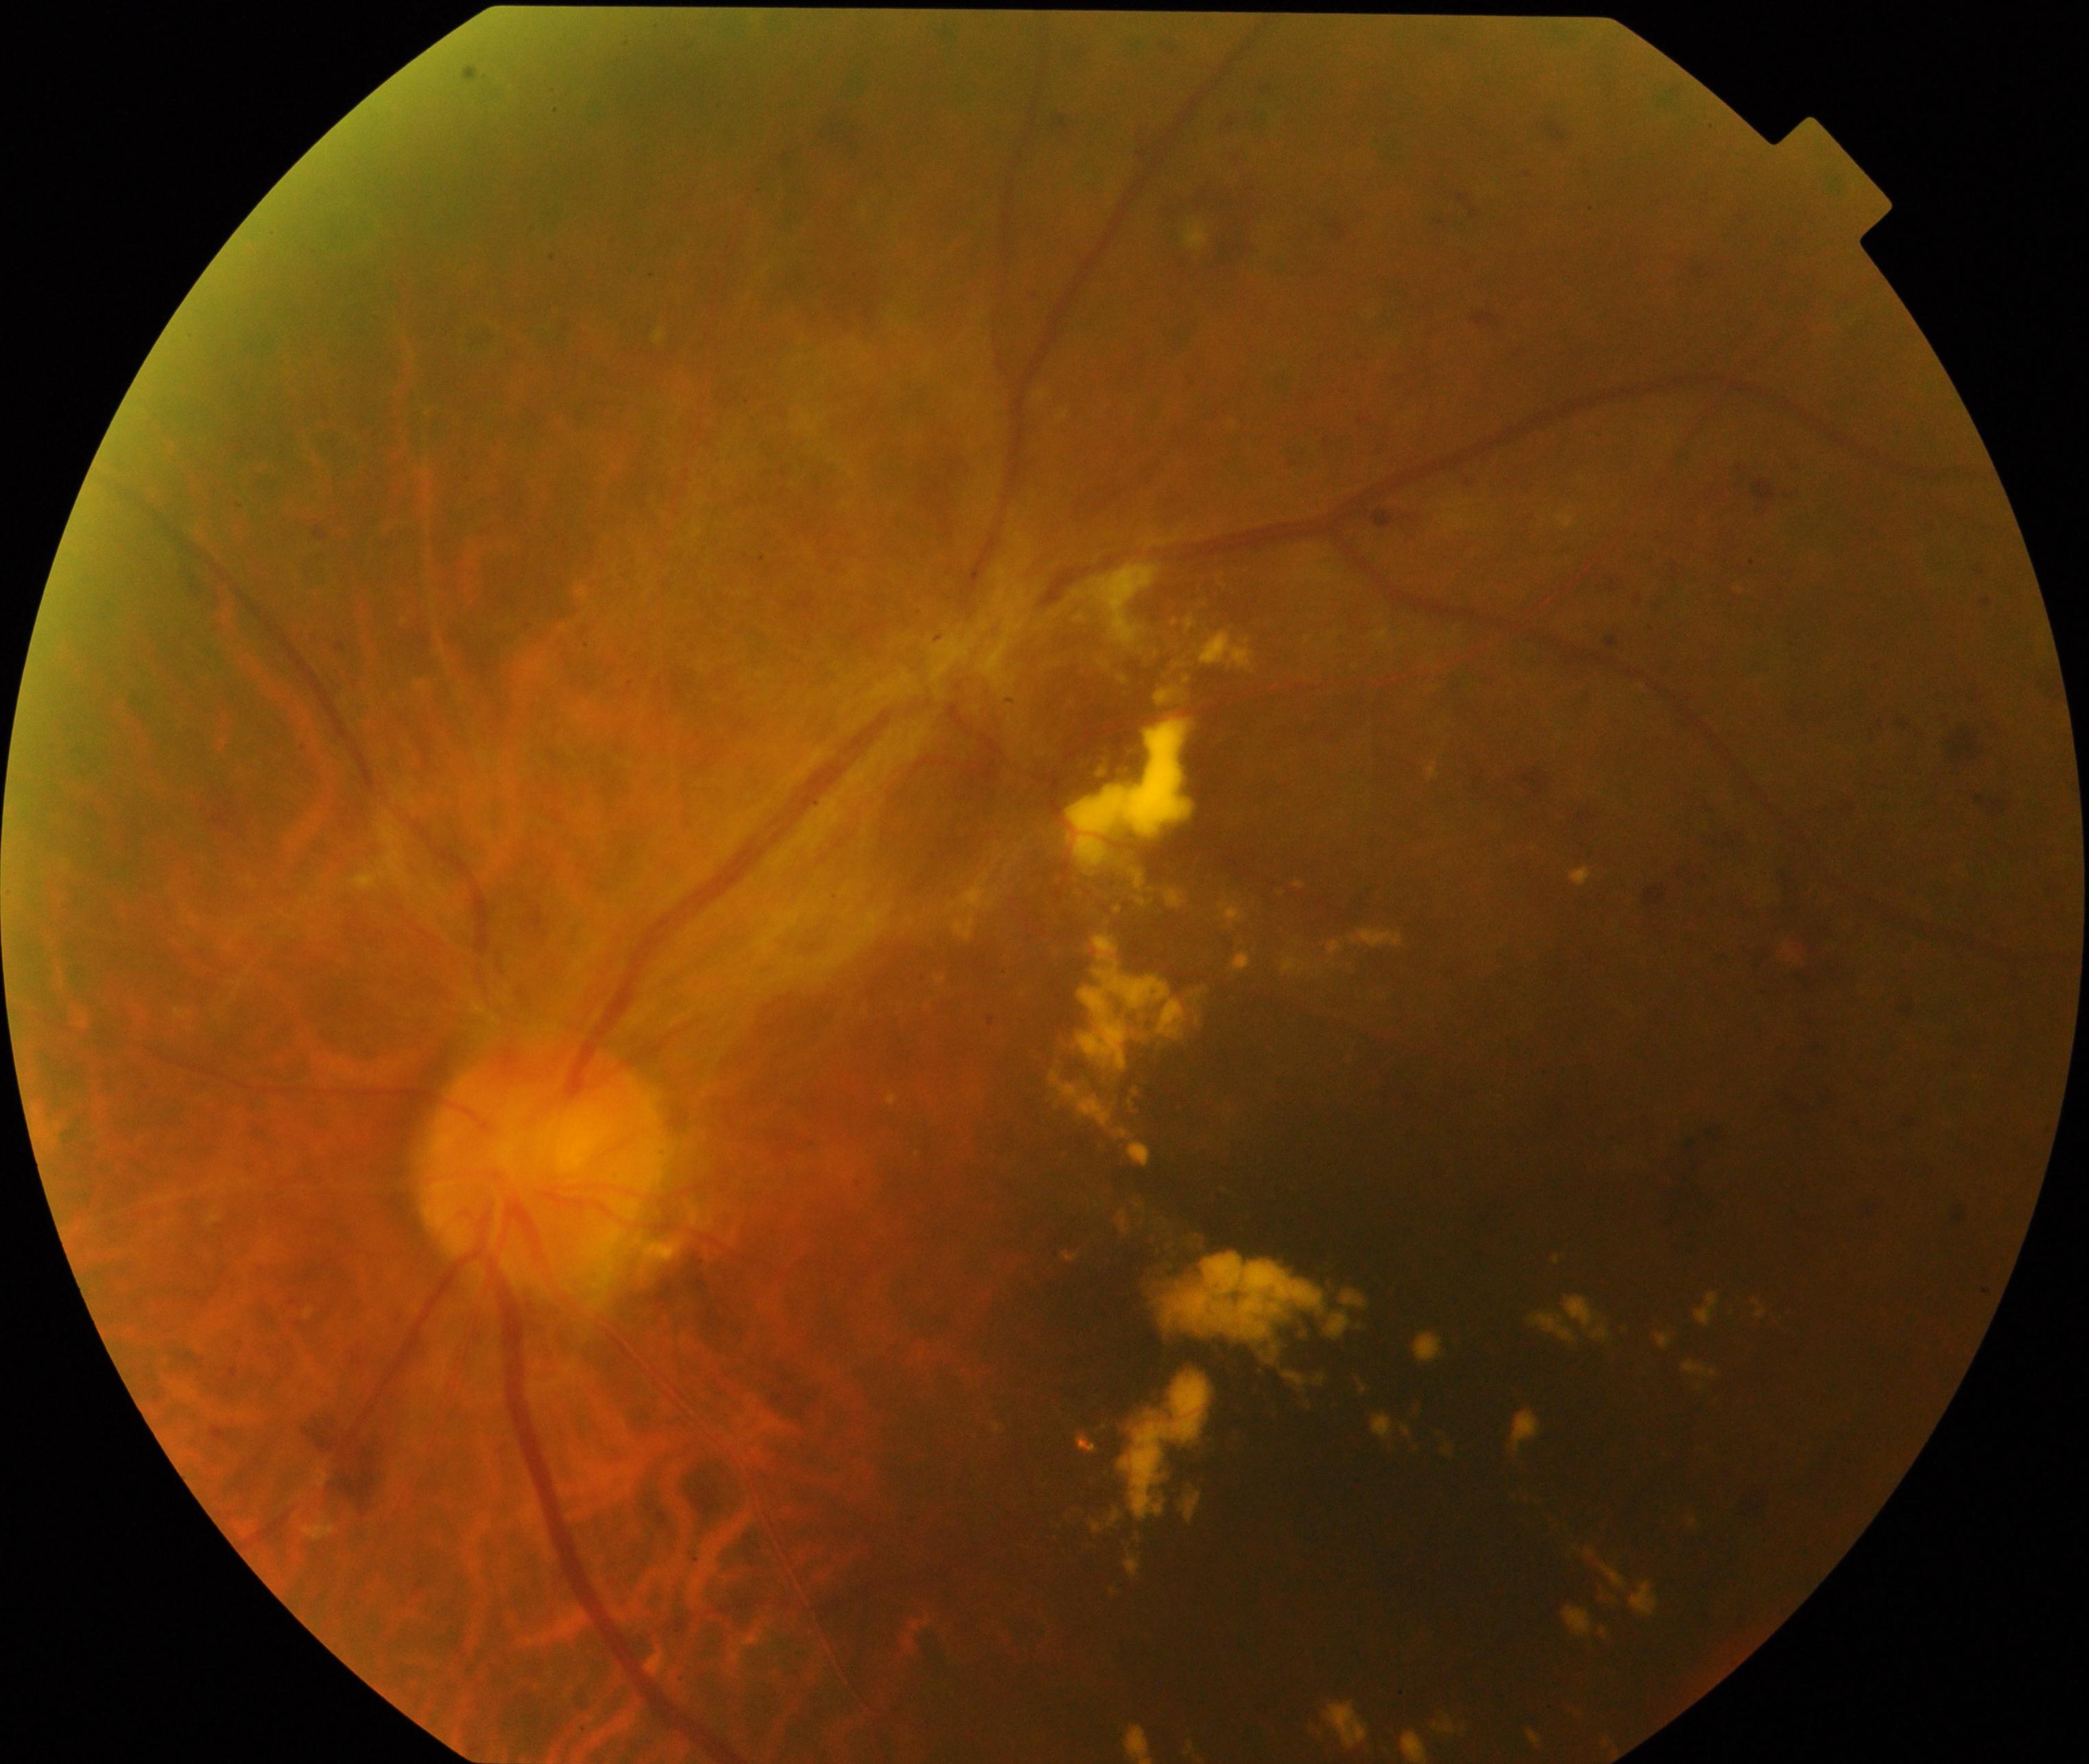 Impression: severe non-proliferative or proliferative diabetic retinopathy.